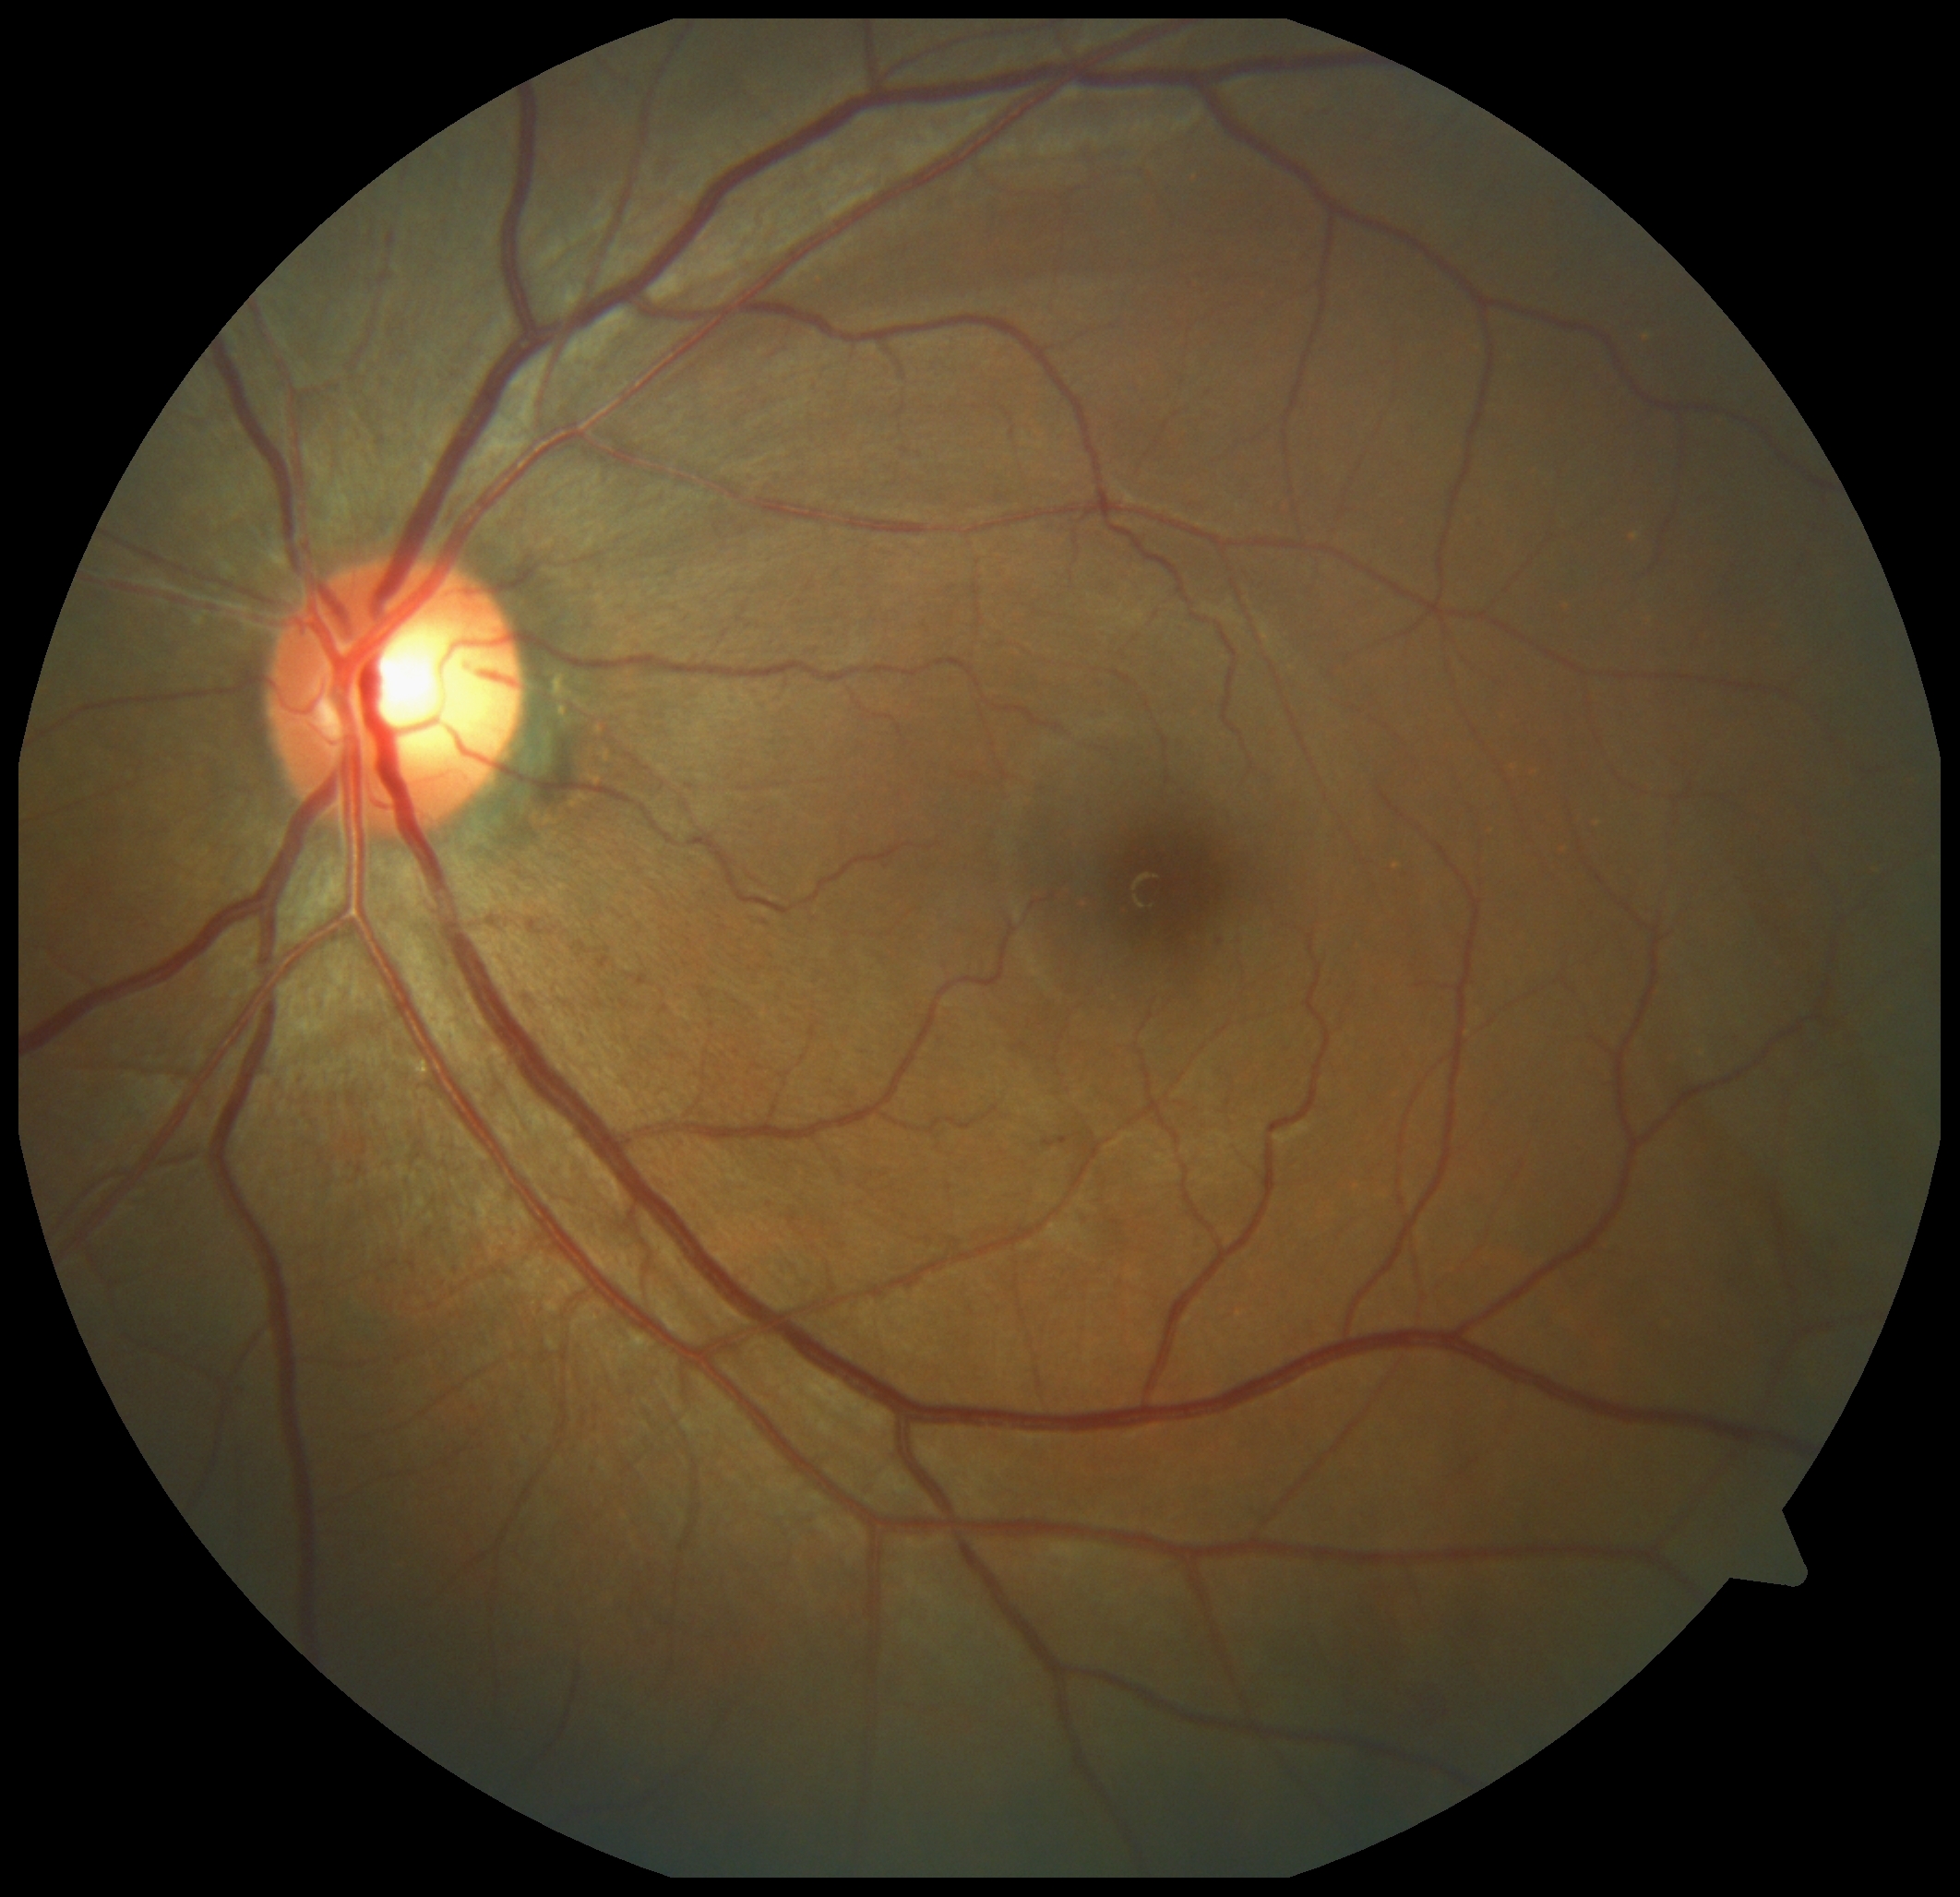 Diabetic retinopathy (DR): grade 1 (mild NPDR) — presence of microaneurysms only.